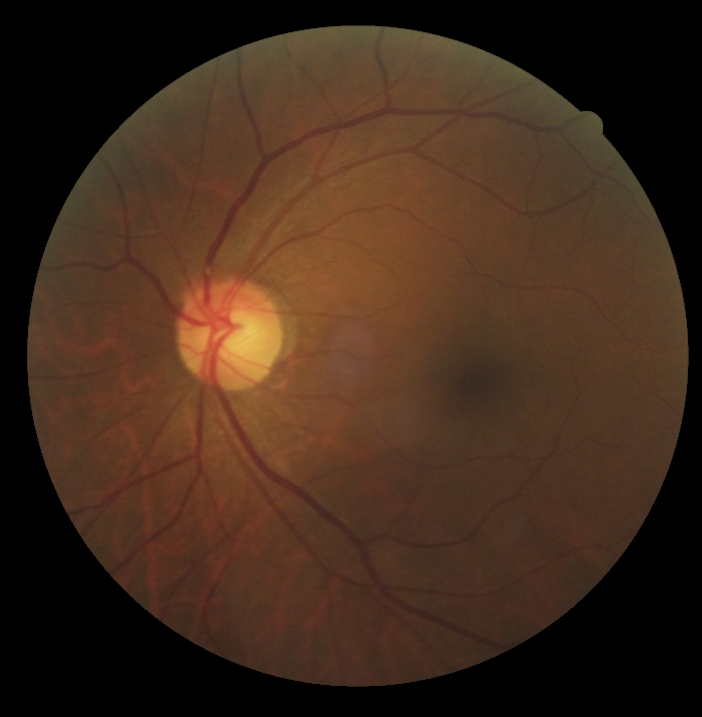

Diabetic retinopathy (DR) is no apparent retinopathy (grade 0).